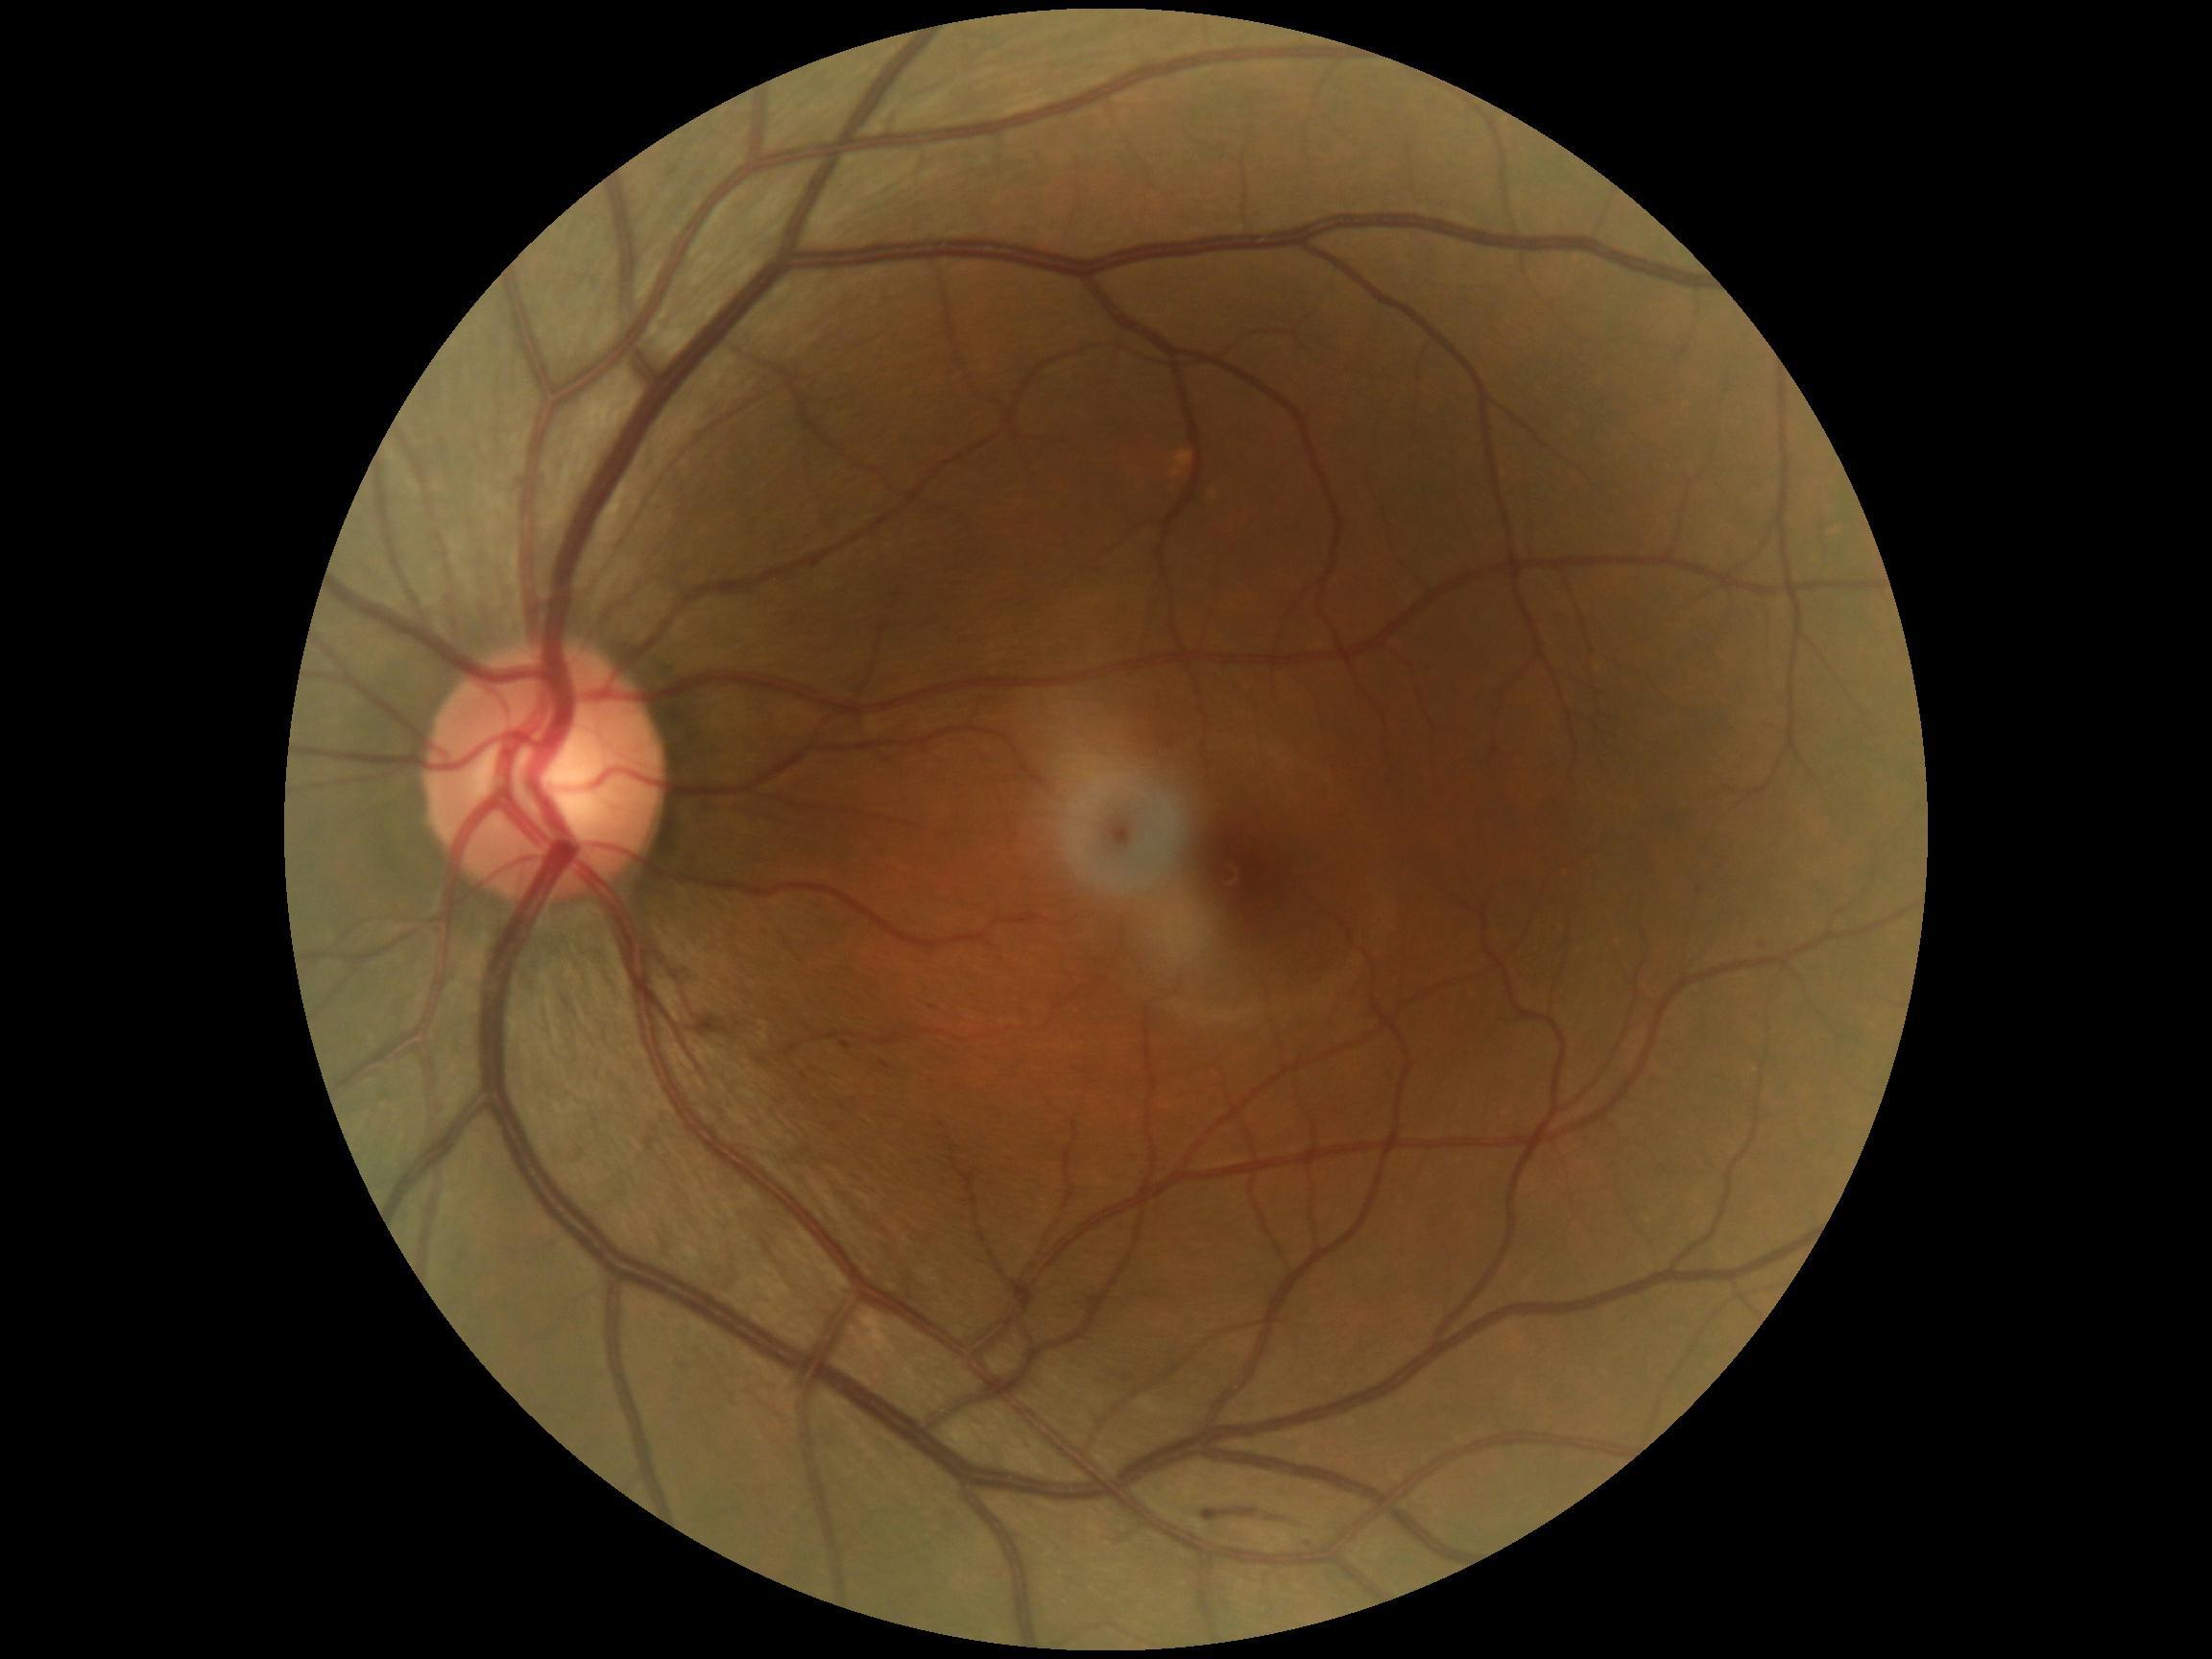

Diabetic retinopathy grade: 2 (moderate NPDR)
Lesions identified (partial list):
soft exudates: none identified
hard exudates: none identified
microaneurysms (subset): <box>841,1043,853,1051</box>; <box>879,1061,891,1070</box>
hemorrhages (subset): <box>1199,1507,1308,1531</box>